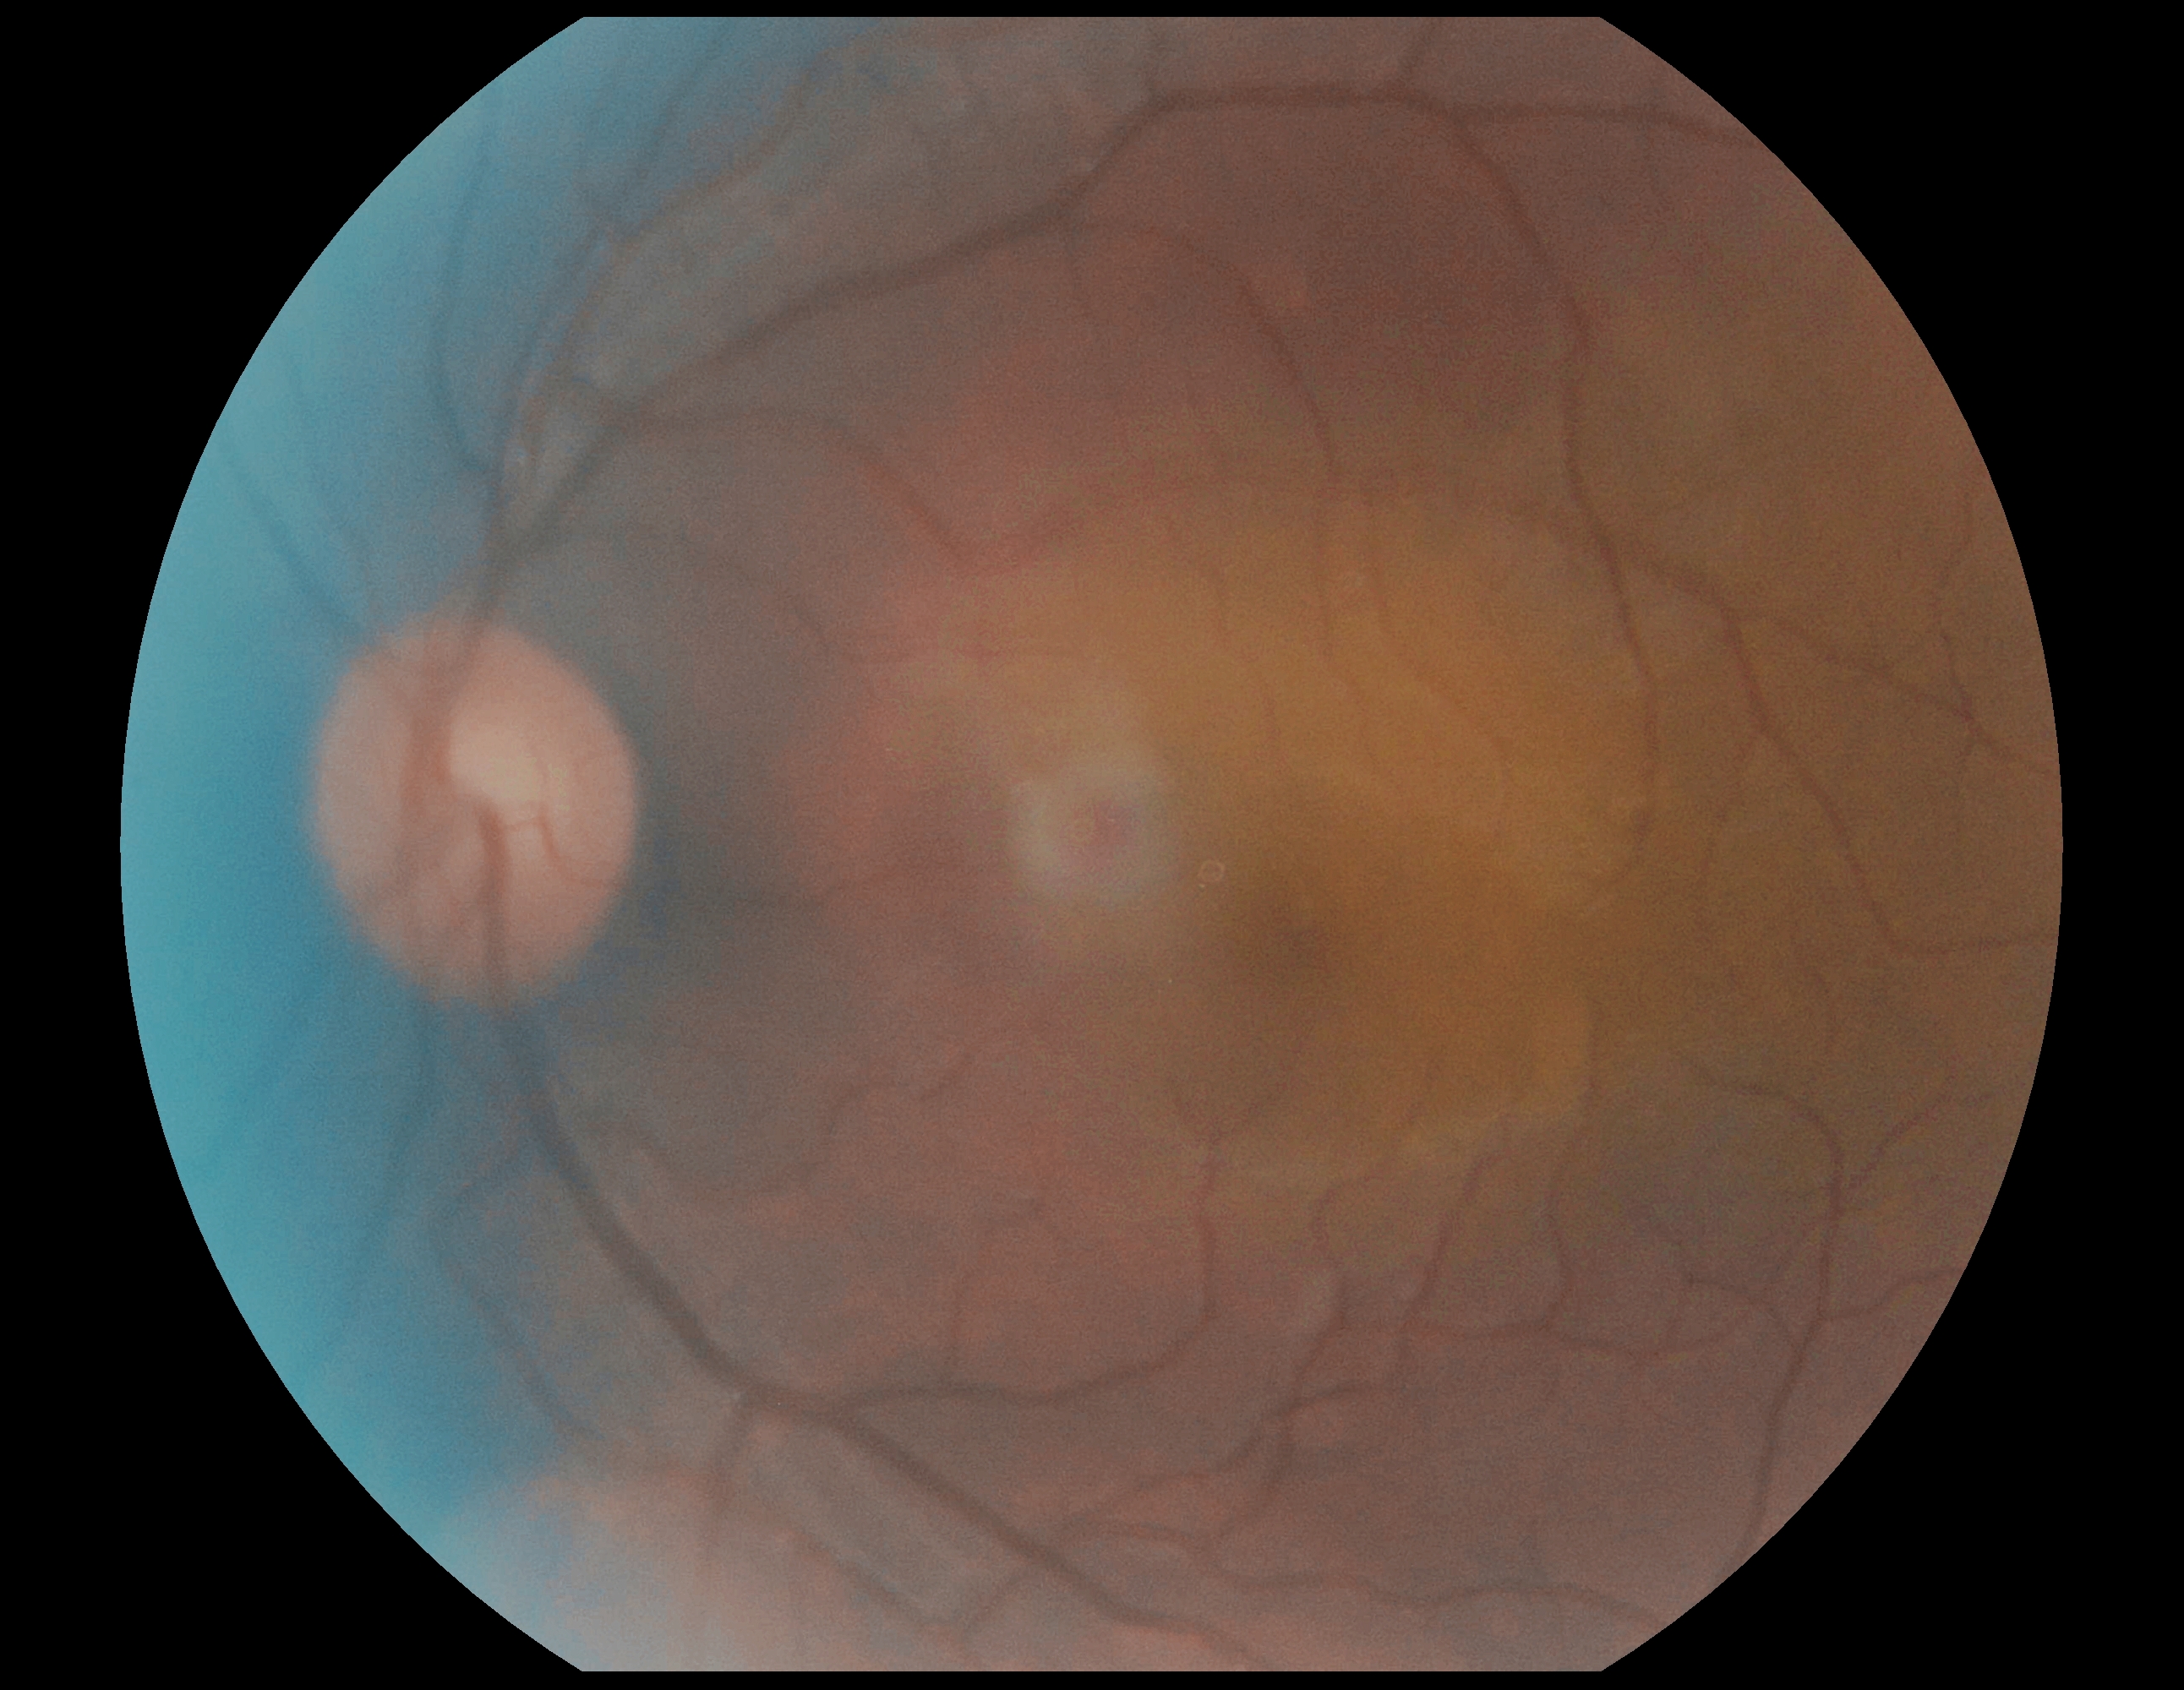

DR severity@no apparent retinopathy (grade 0).